Without pupil dilation.
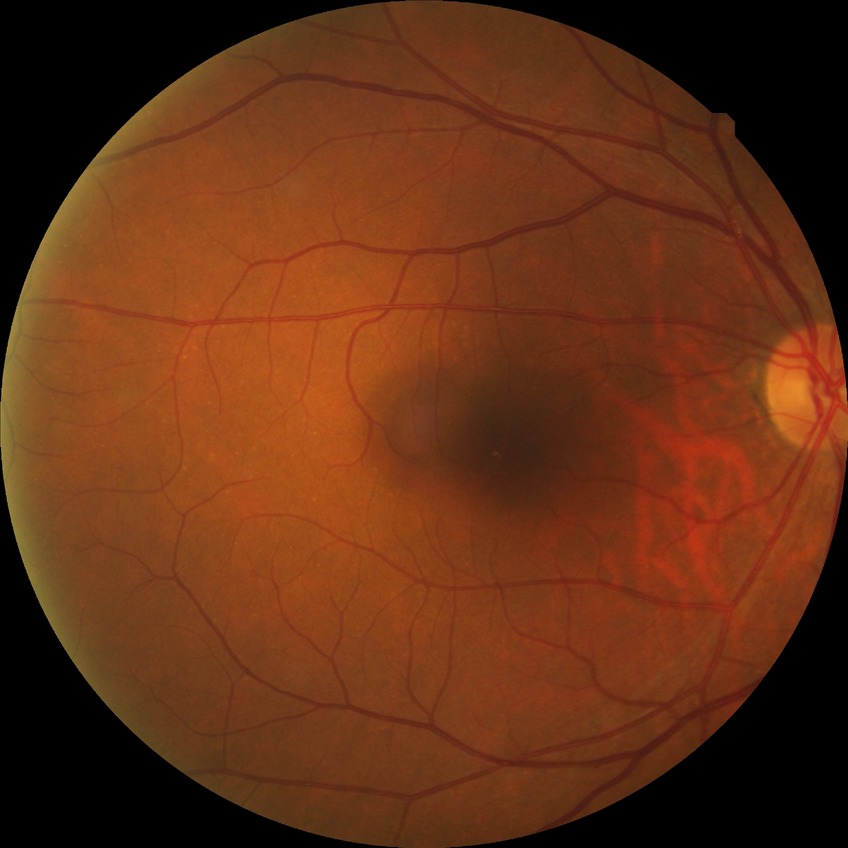 DR stage is NDR.